Infant wide-field retinal image: 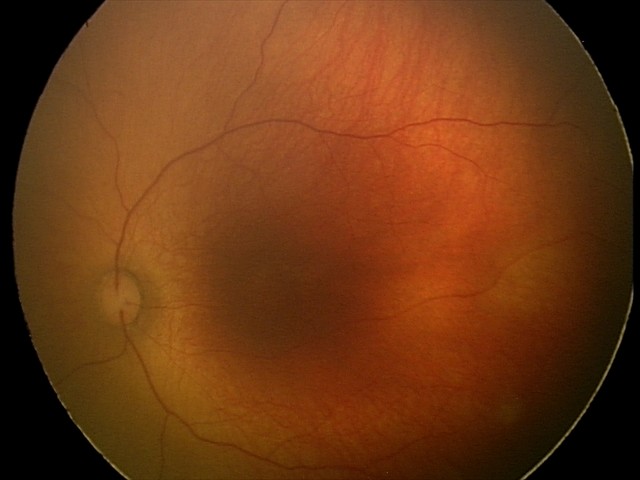 Normal screening examination.